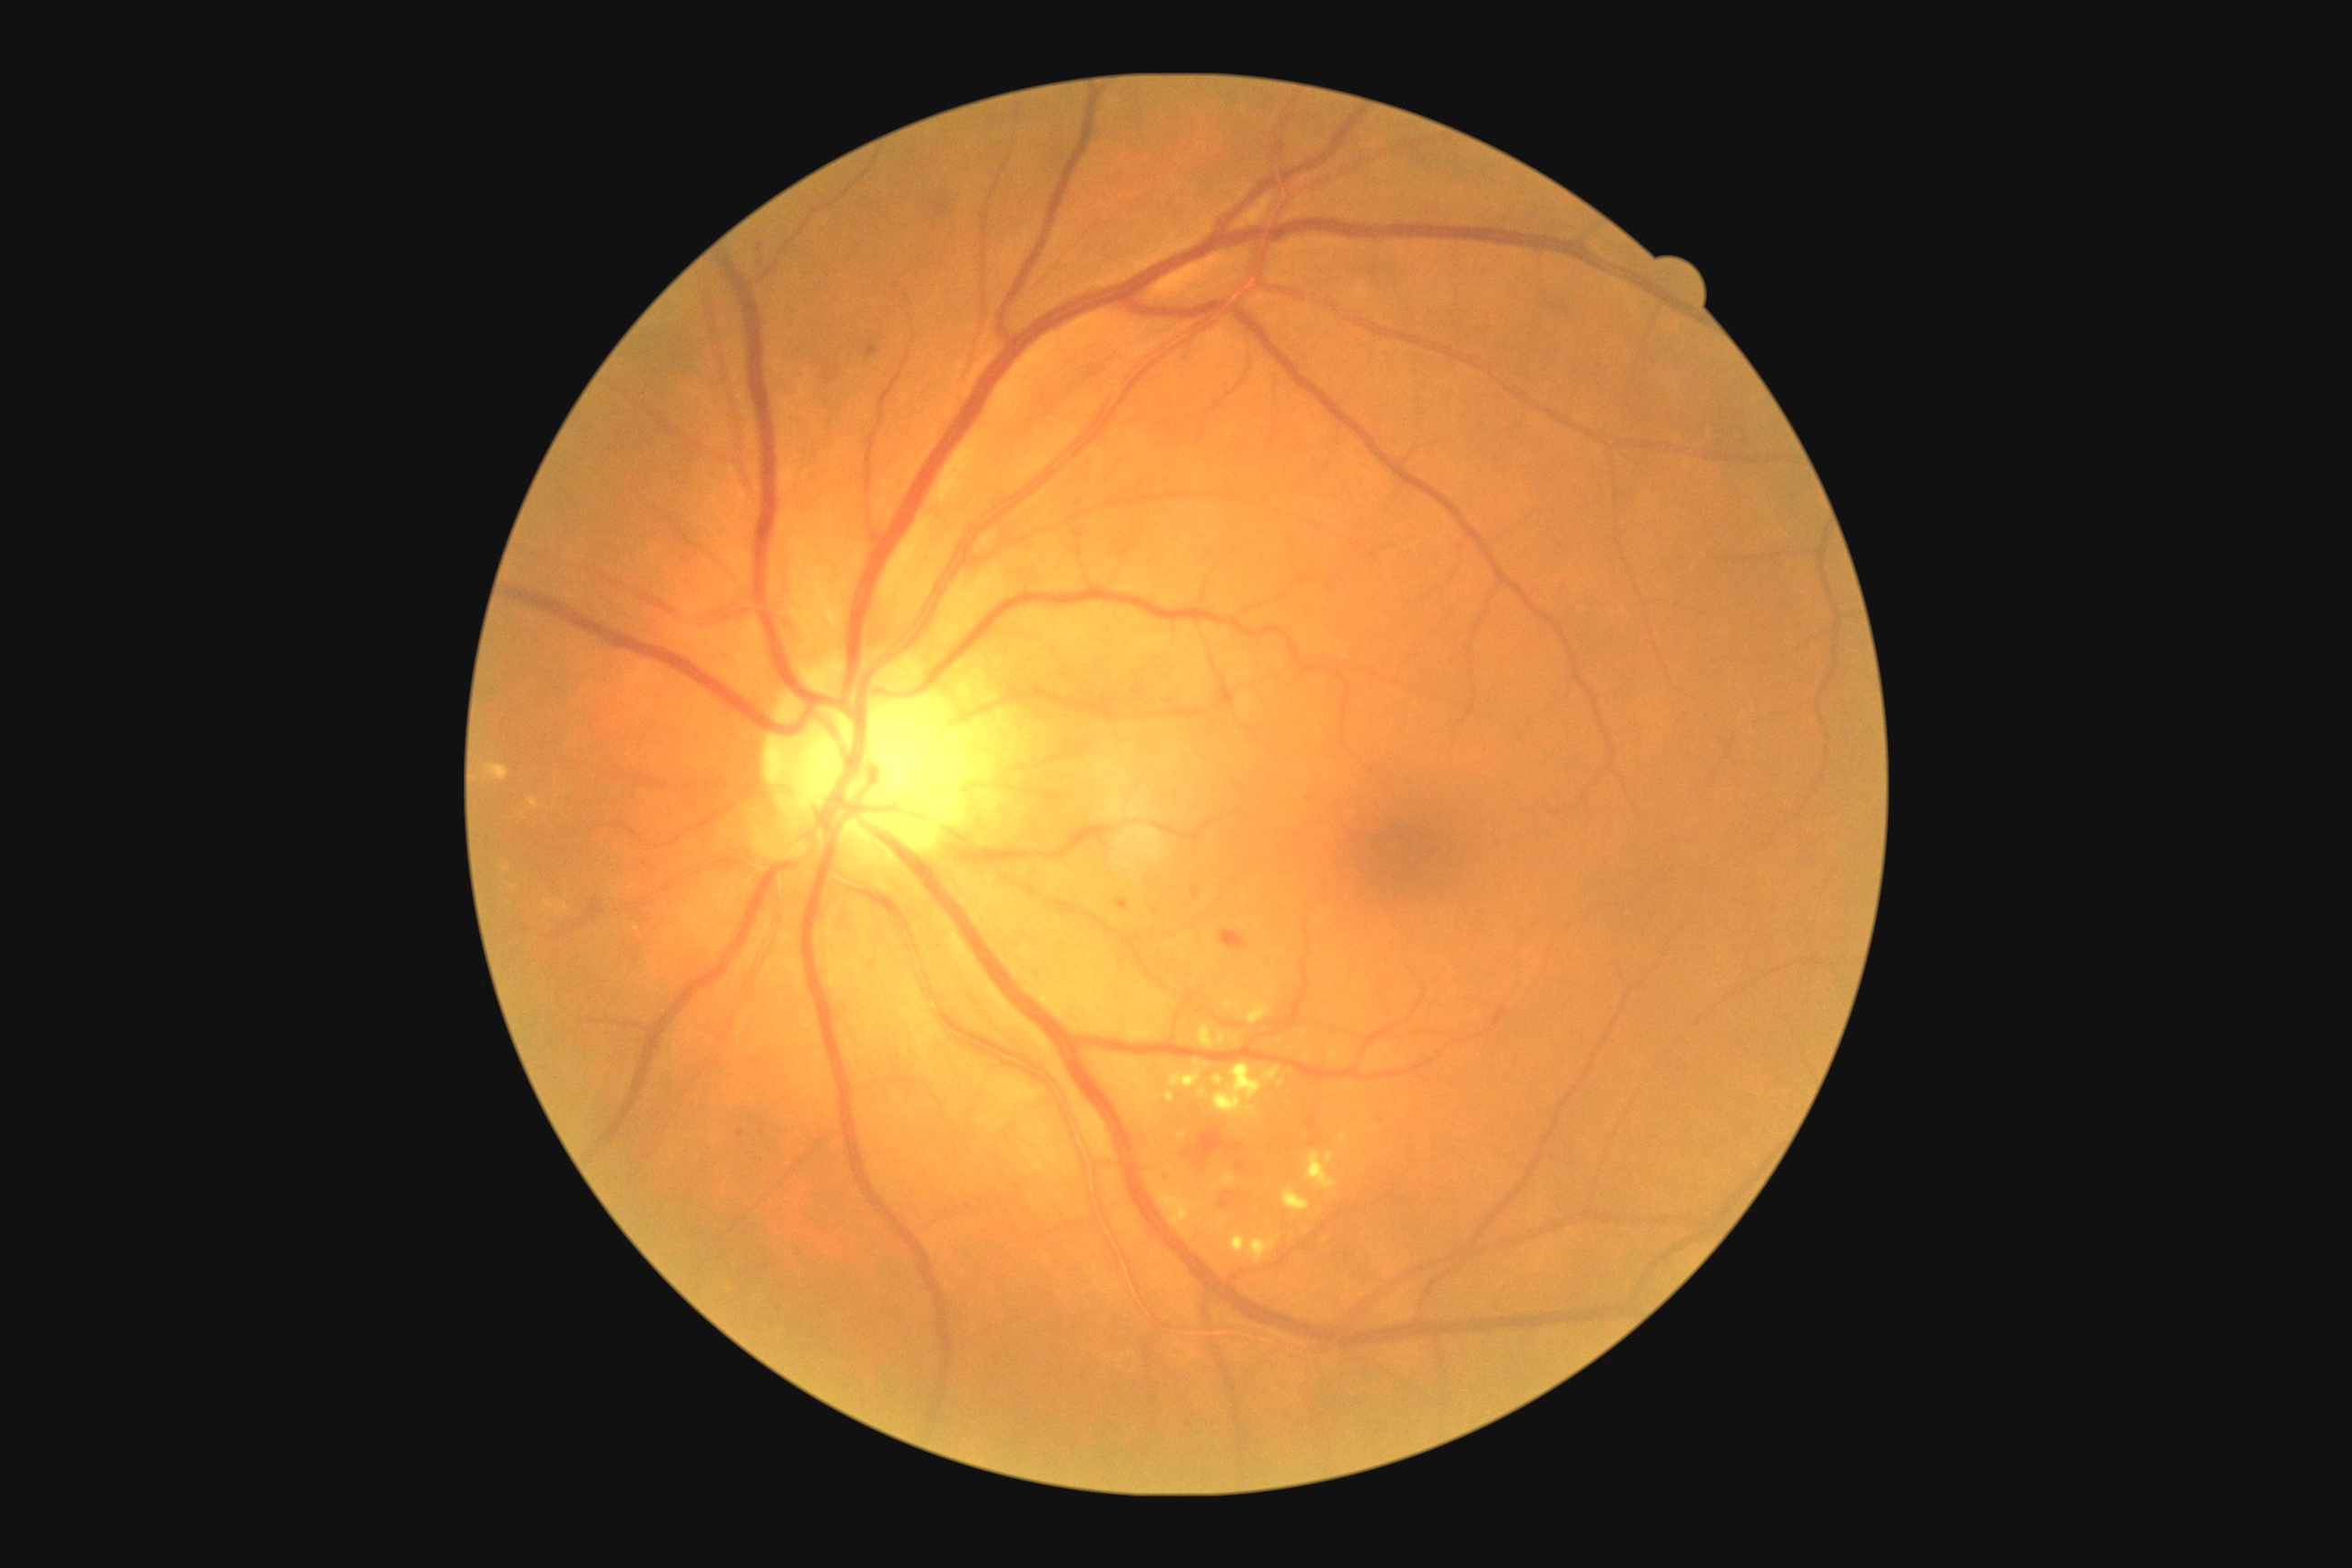
Diabetic retinopathy grade is 2 (moderate NPDR)
Selected lesions:
• soft exudates: not present
• hard exudates (subset): 1326:1153:1335:1164; 527:799:538:810; 1219:1034:1226:1044; 1213:1063:1264:1117; 1262:1066:1282:1083; 1166:1092:1175:1102; 1304:1152:1338:1190; 1213:1170:1237:1190; 1168:1070:1202:1088; 1300:1032:1308:1041; 485:765:509:781
• Small hard exudates approximately at <point>1236, 1039</point>; <point>637, 929</point>; <point>1197, 1062</point>; <point>1282, 1084</point>
• hemorrhages: 1113:897:1130:912; 1182:1153:1191:1159; 1220:1191:1237:1210; 1231:1146:1240:1153; 591:901:600:919; 1220:932:1250:950; 1161:1171:1173:1184; 1166:698:1175:705; 1306:1117:1315:1128; 867:346:877:358; 1237:1162:1246:1171; 1191:1128:1226:1162; 1193:887:1200:897
• Small hemorrhages approximately at <point>741, 1133</point>; <point>1271, 1148</point>; <point>1311, 799</point>; <point>825, 377</point>; <point>1373, 771</point>; <point>1380, 1119</point>
• microaneurysms: not present